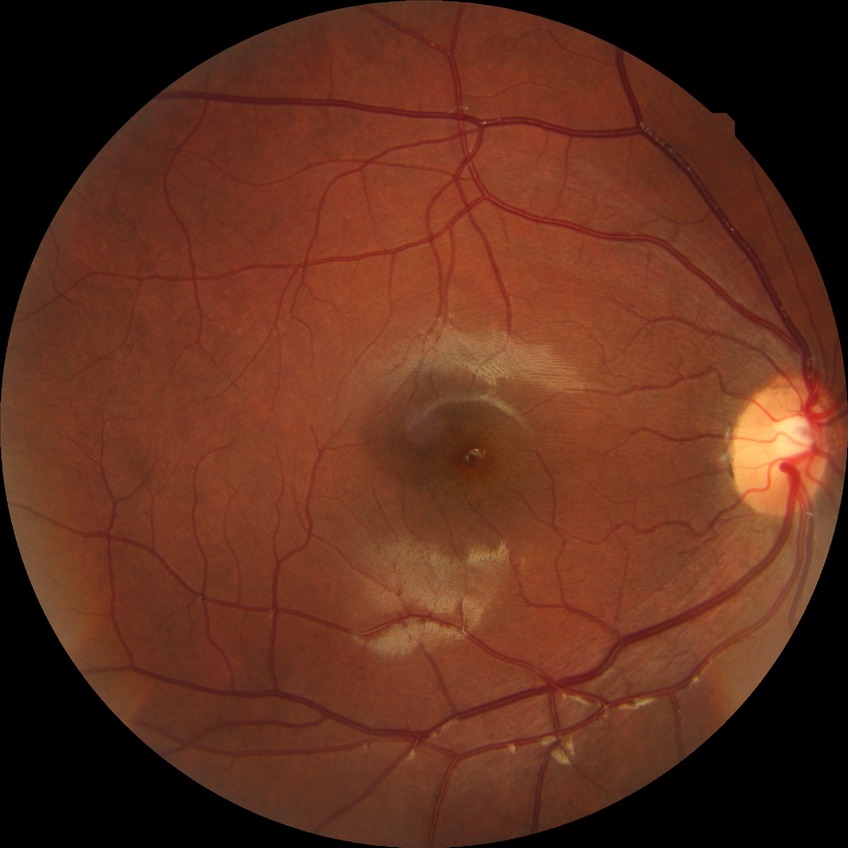

Diabetic retinopathy (DR): NDR (no diabetic retinopathy).